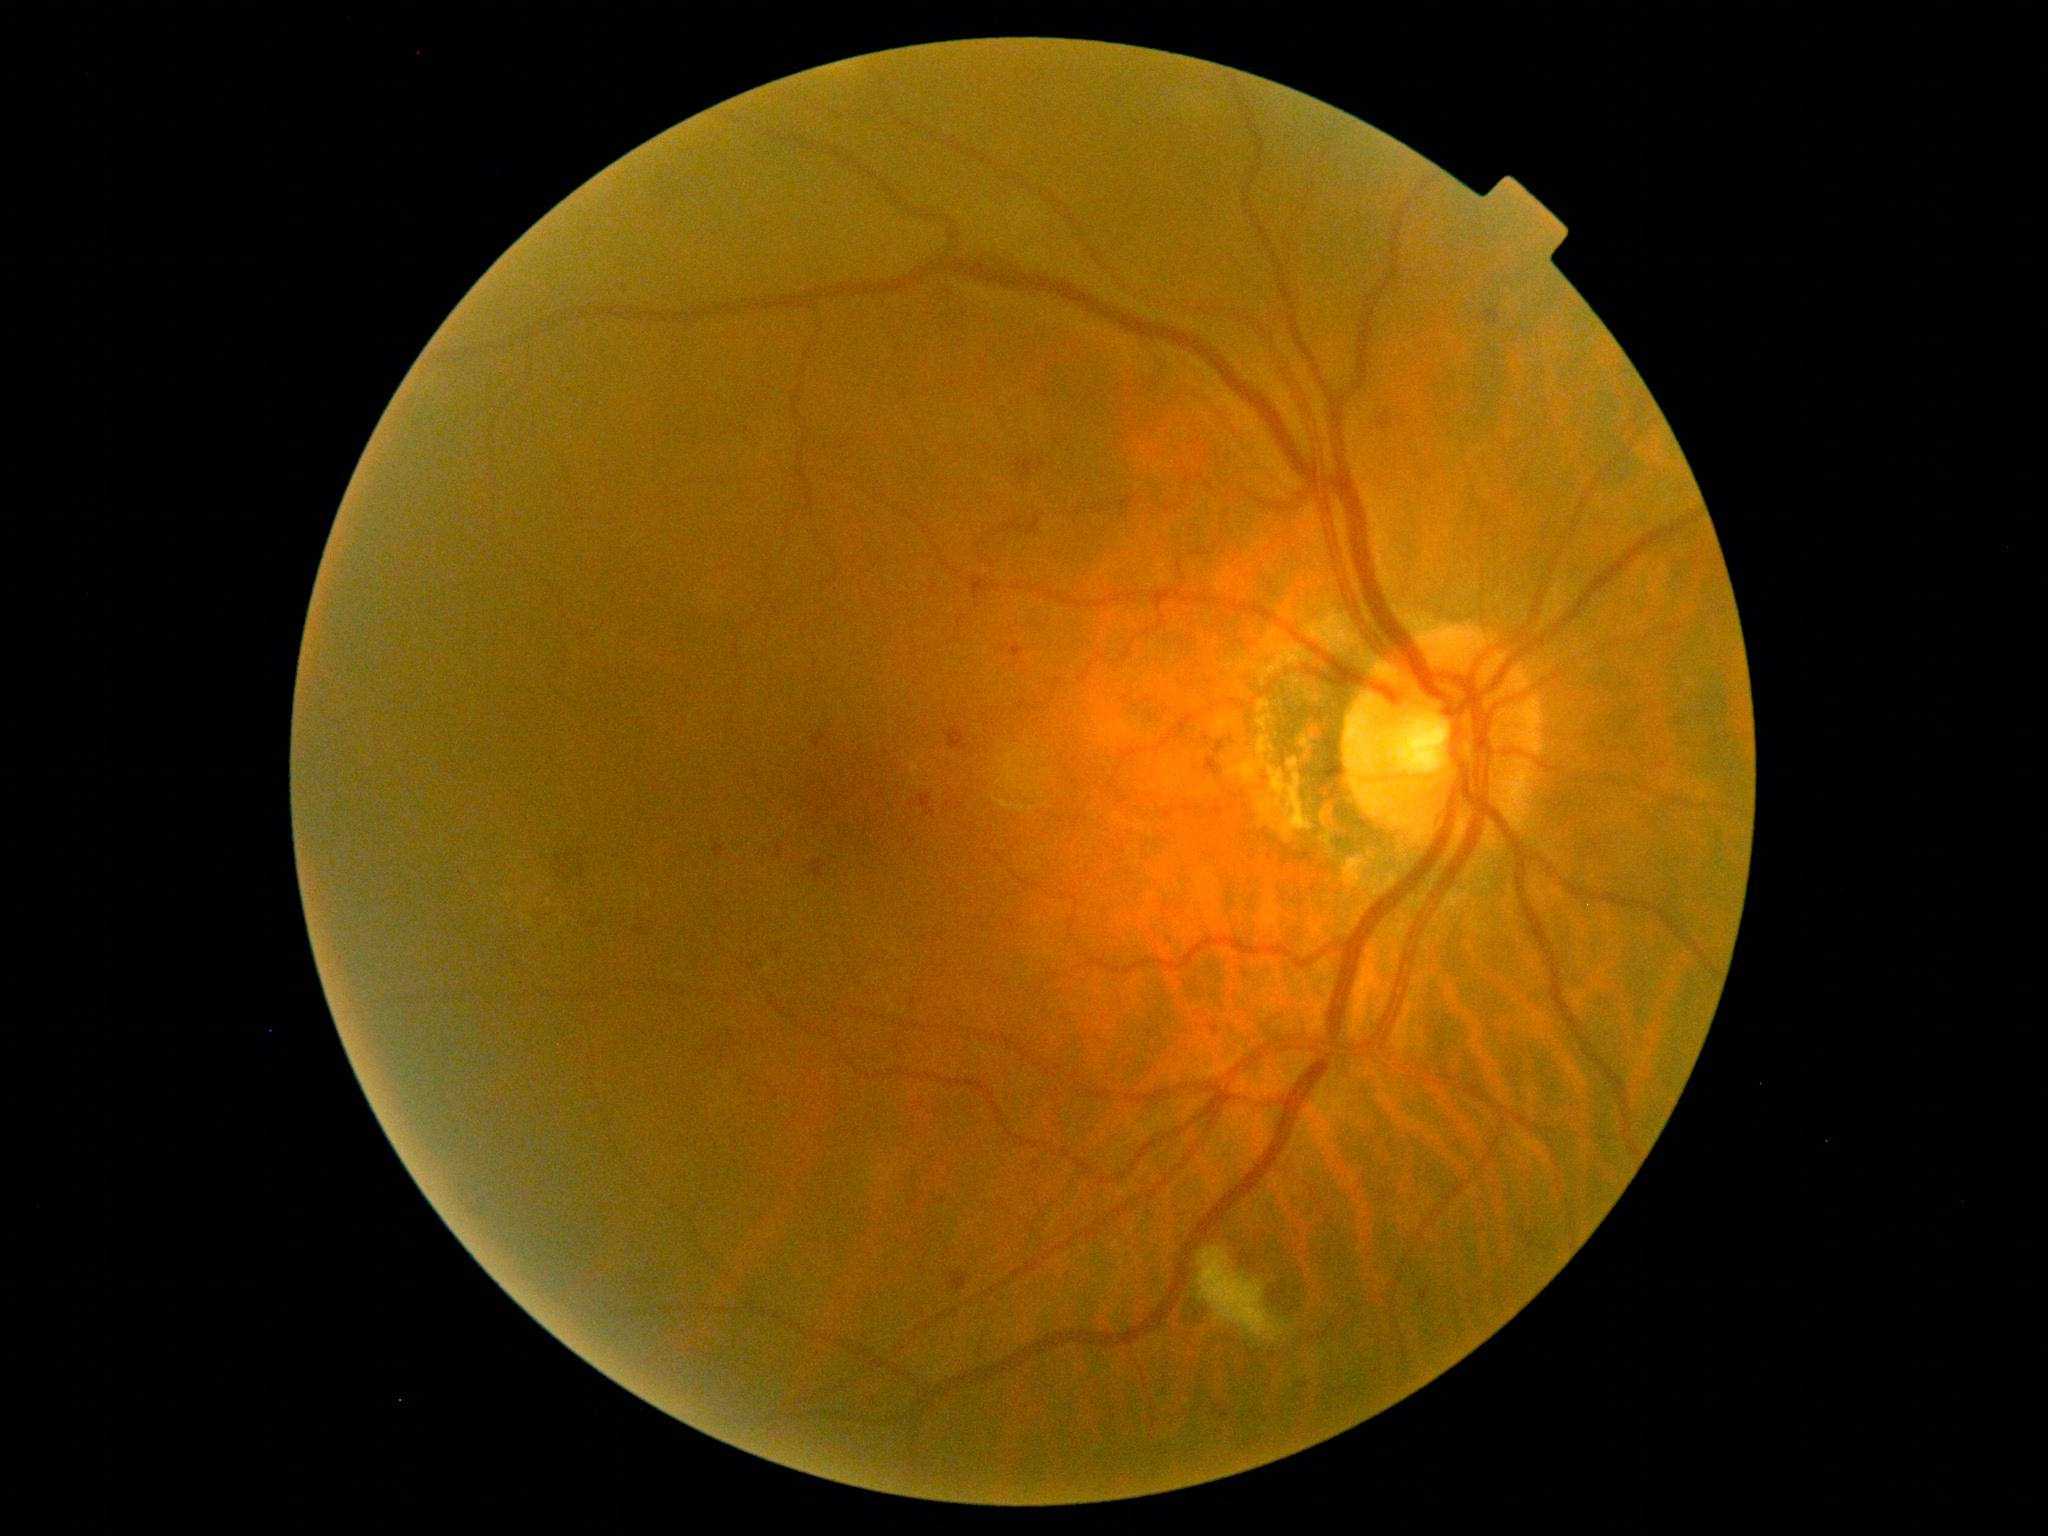 Retinopathy is grade 2 (moderate NPDR). Disease class: non-proliferative diabetic retinopathy.